2352x1568. 45-degree field of view. Retinal fundus photograph
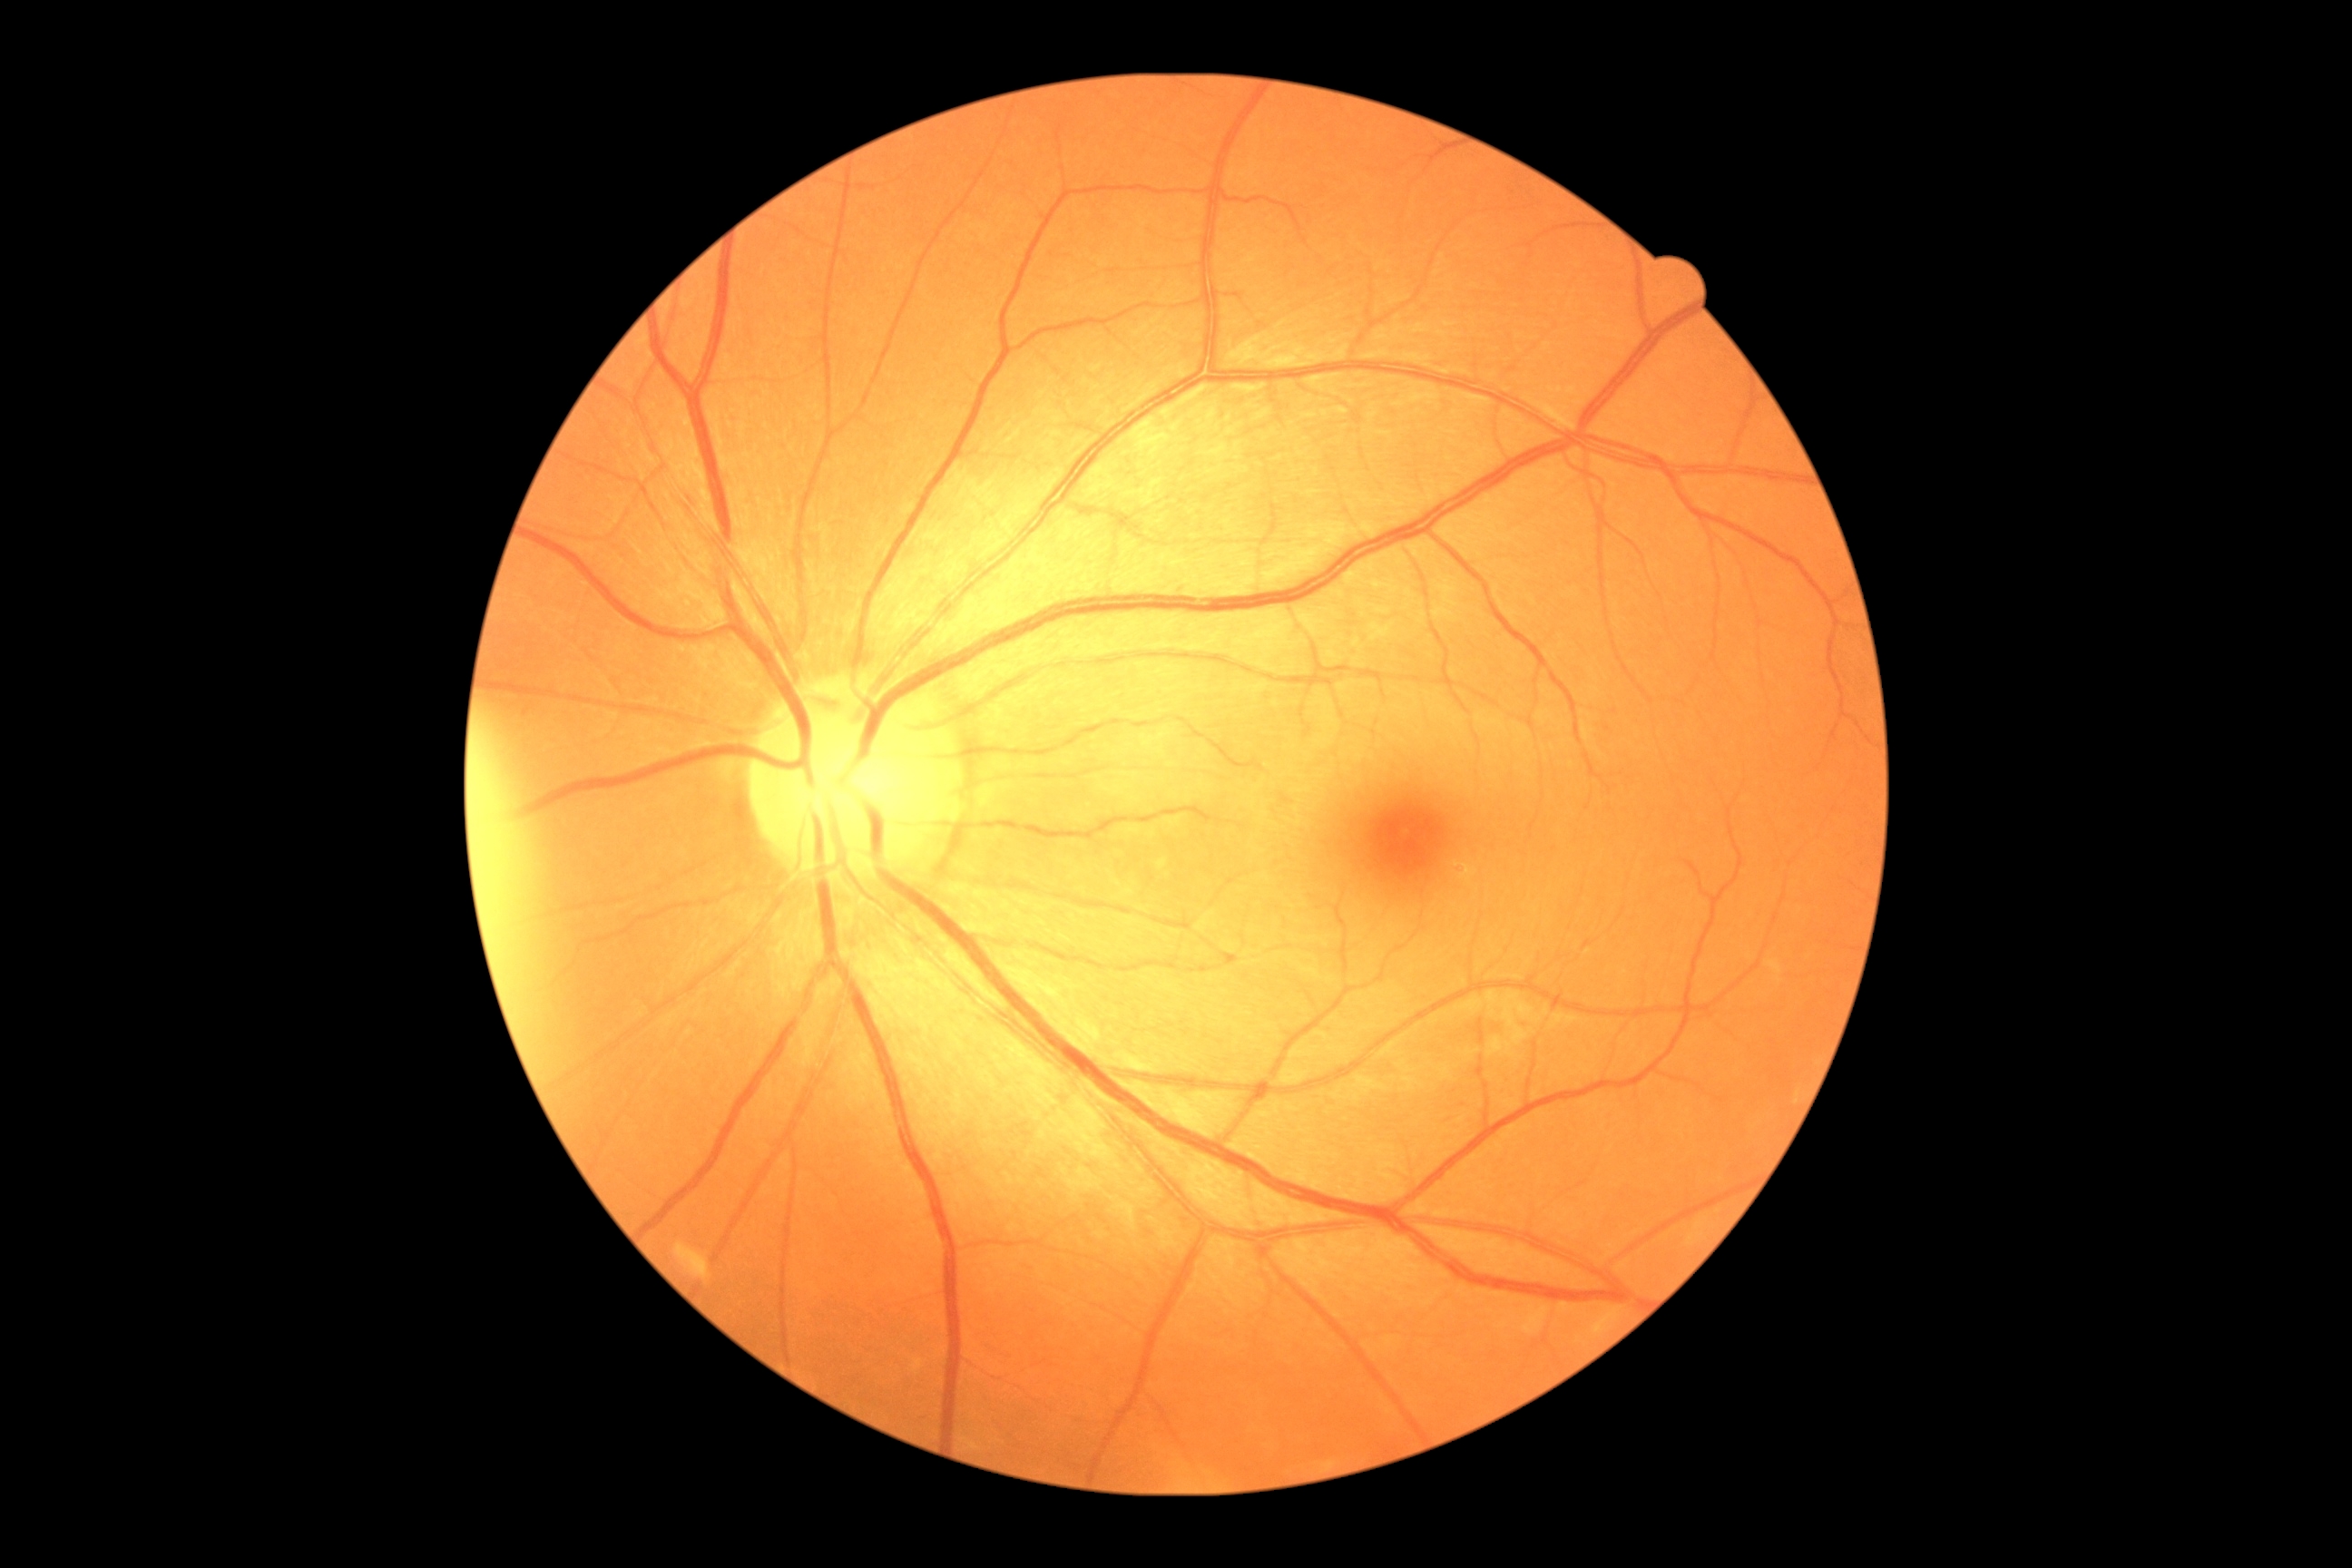
DR severity: grade 1 (mild NPDR).
The retinopathy is classified as non-proliferative diabetic retinopathy.